NIDEK AFC-230, diabetic retinopathy graded by the modified Davis classification, image size 848x848, fundus photo:
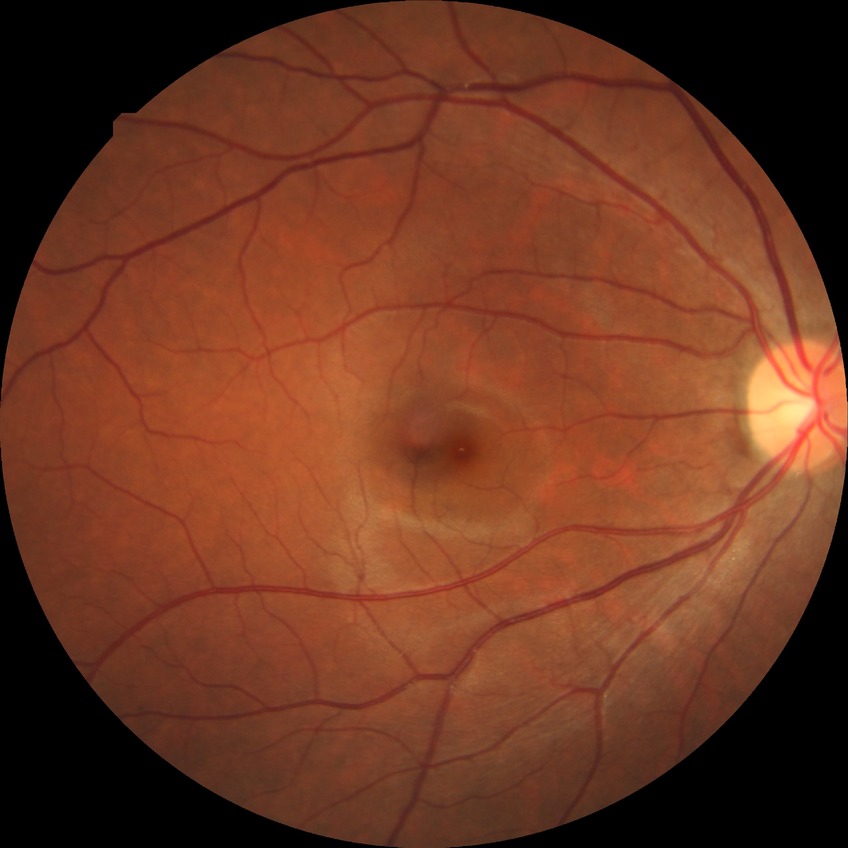

{"davis_grade": "NDR (no diabetic retinopathy)"}